Pediatric retinal photograph (wide-field) · 640 by 480 pixels — 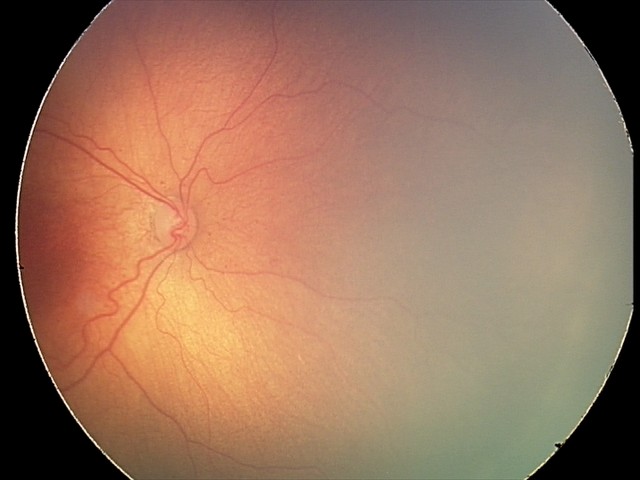
Without plus disease.
Diagnosis from this screening exam: retinopathy of prematurity stage 2.